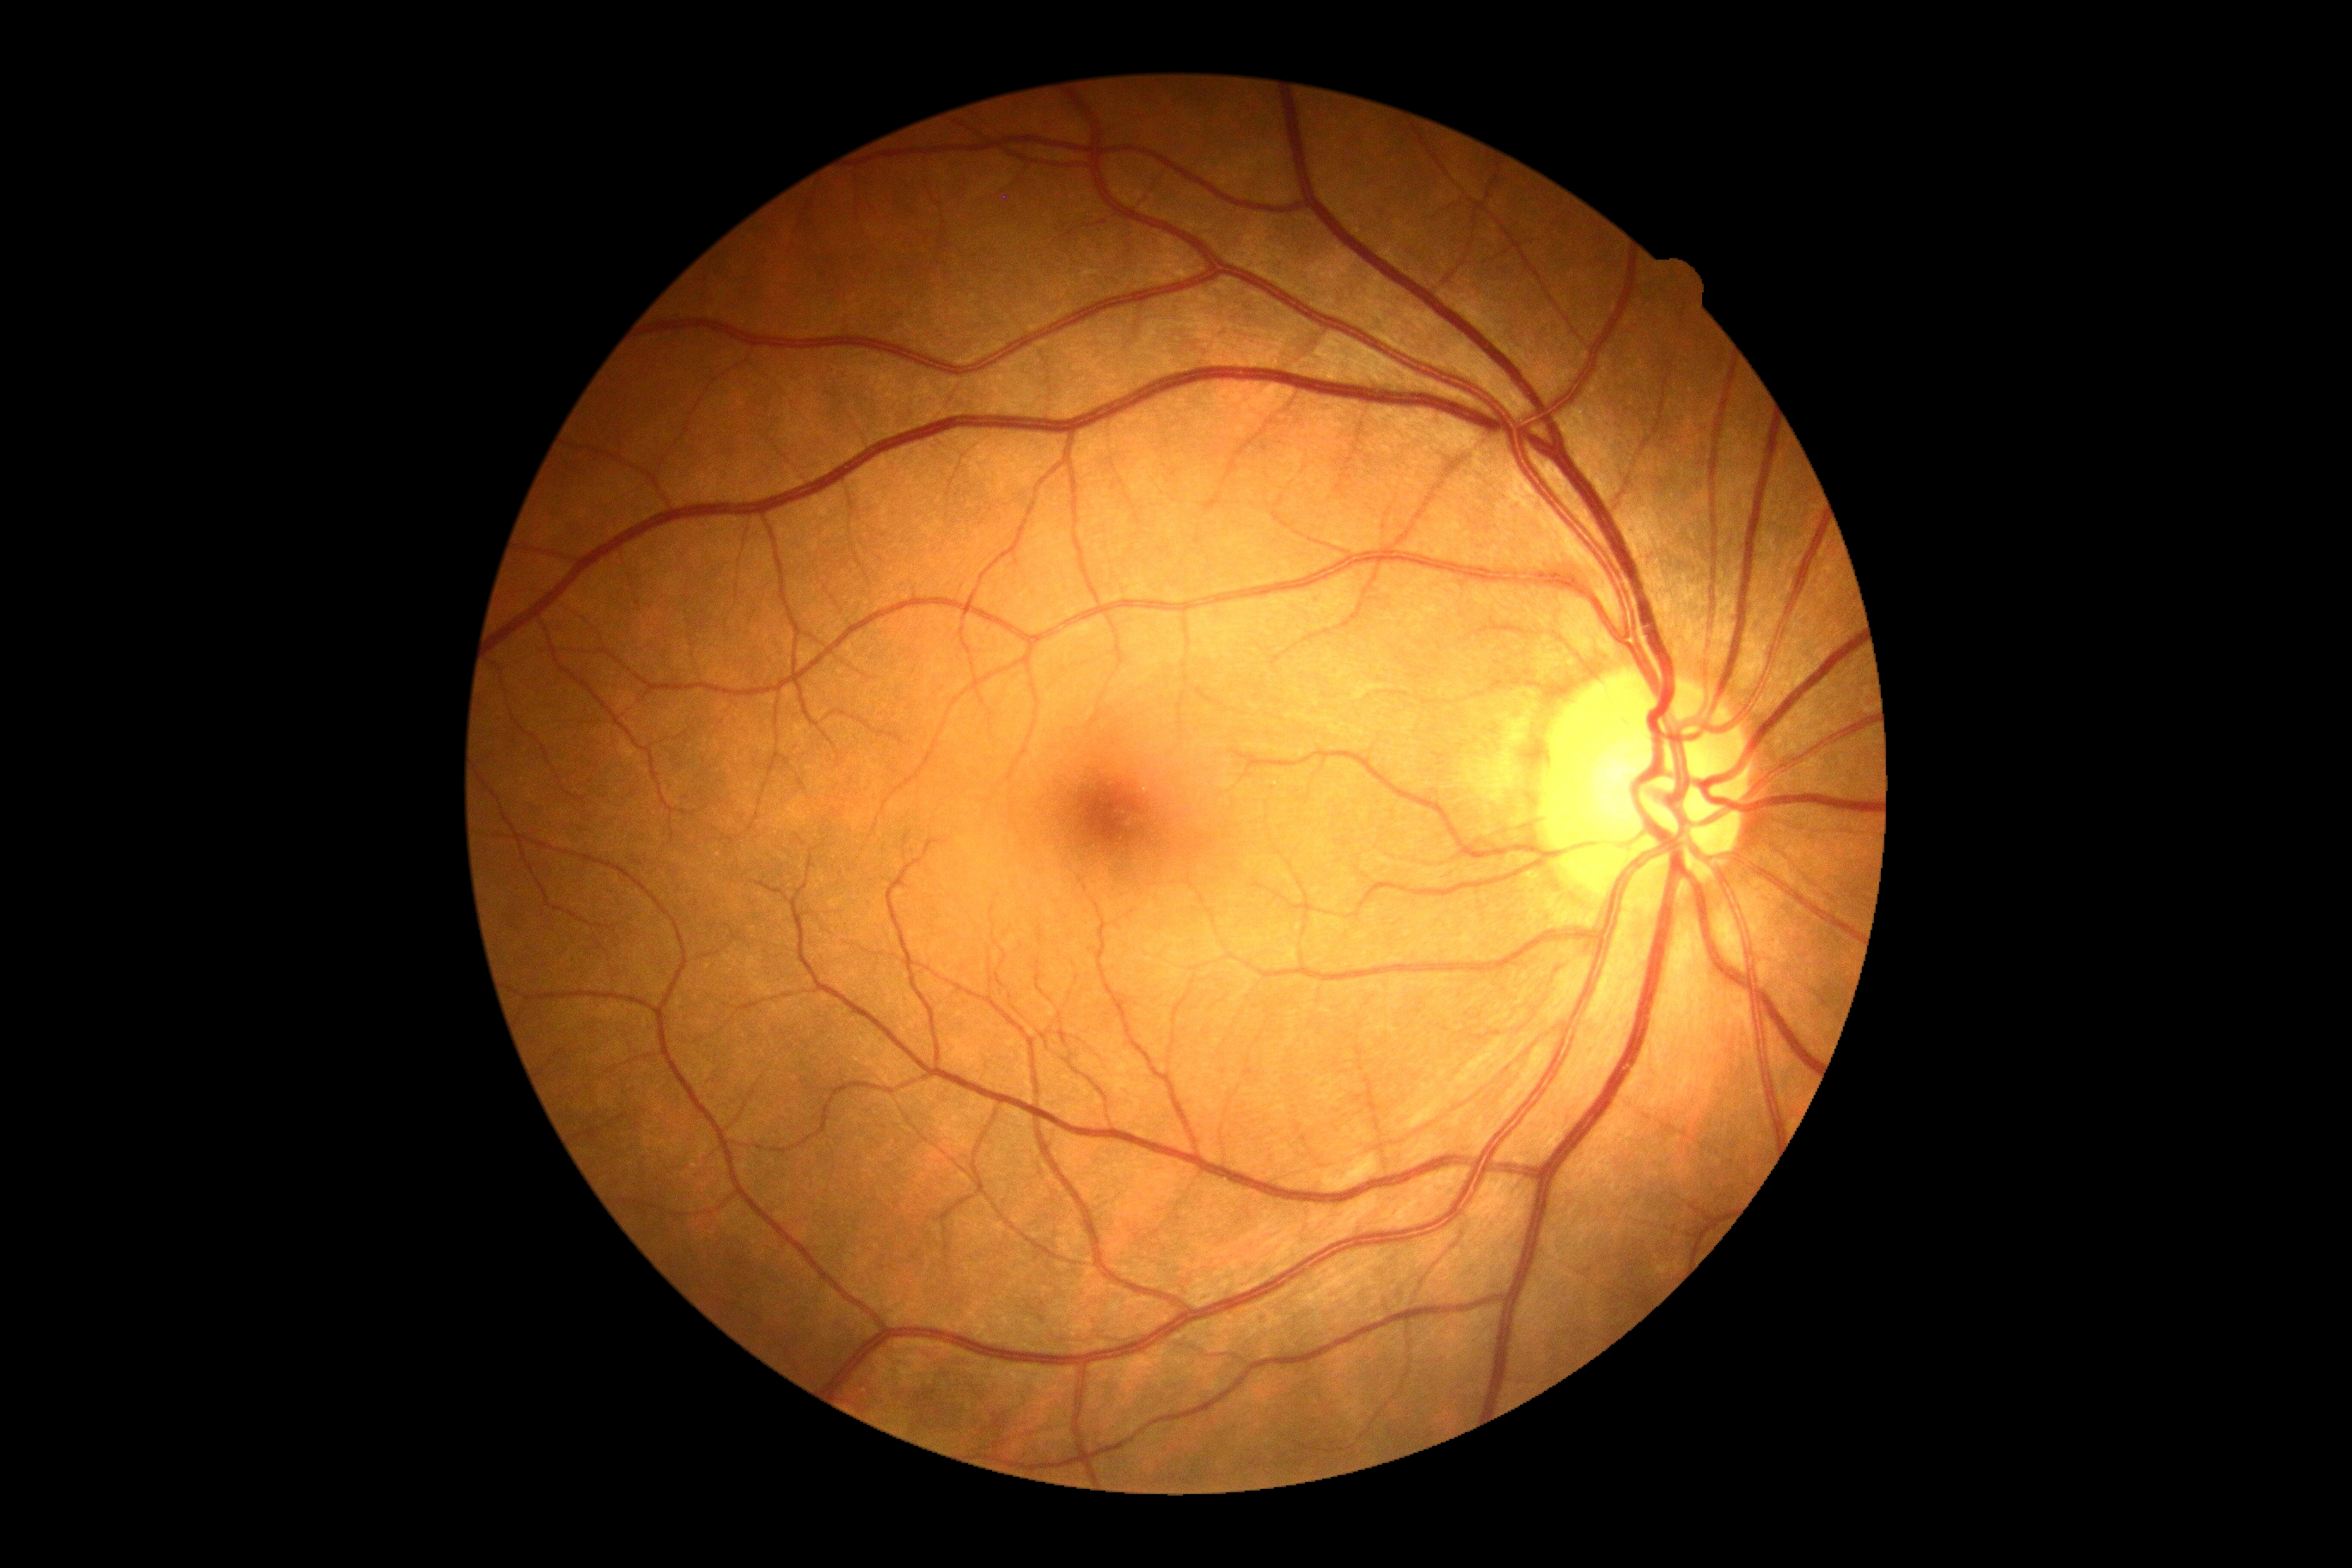

- DR severity — grade 0 (no apparent retinopathy) — no visible signs of diabetic retinopathy